Wide-field retinal mosaic image.
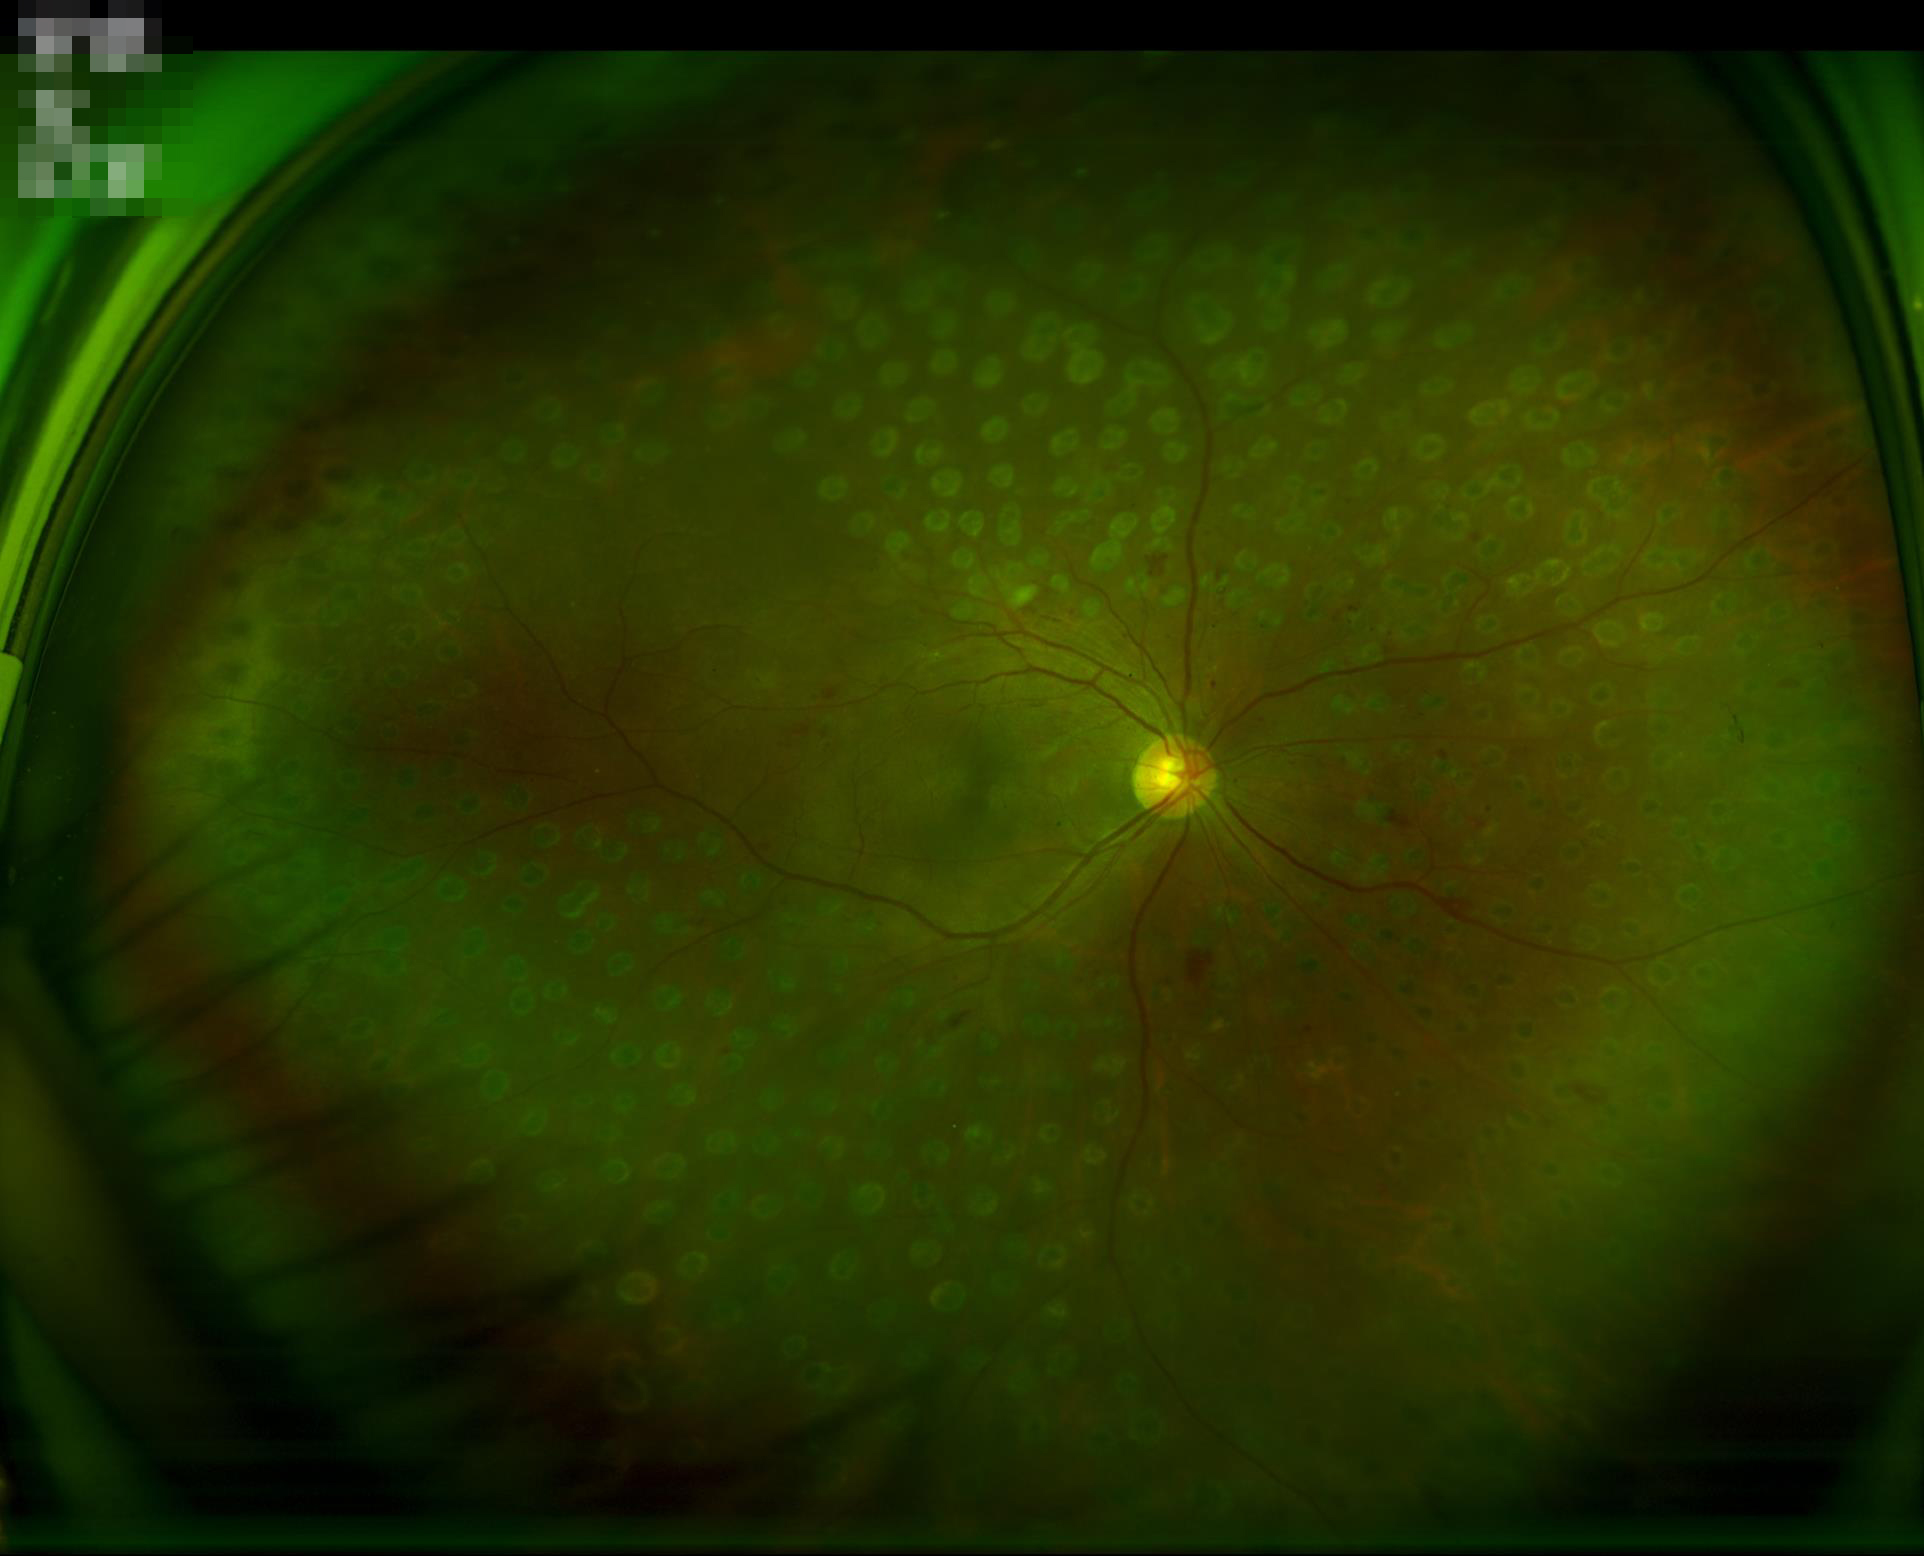

Contrast = satisfactory | Focus = good | Overall image quality = good | Illumination = adequate.